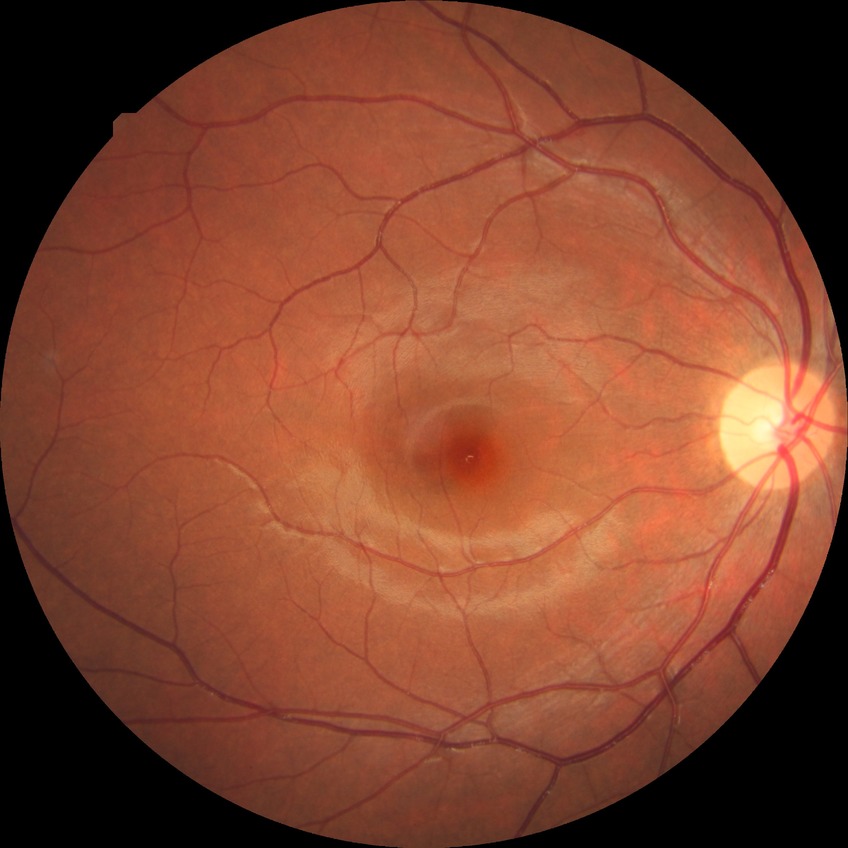

{
  "davis_grade": "no diabetic retinopathy"
}